640 x 480 pixels; Clarity RetCam 3, 130° FOV; infant wide-field retinal image:
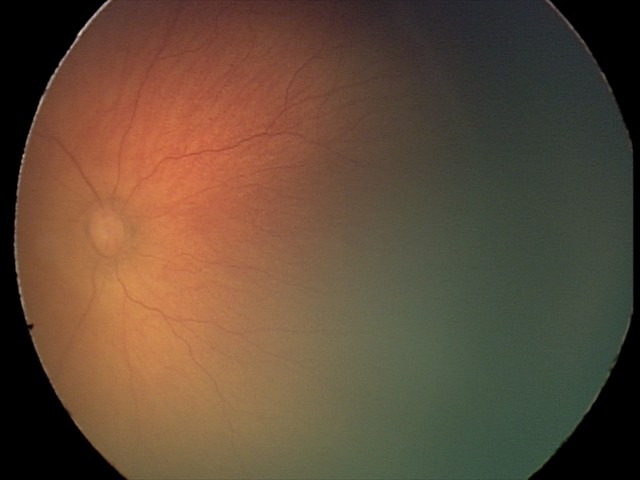

From an examination with diagnosis of retinopathy of prematurity stage 2.